Color fundus photograph, 45° FOV: 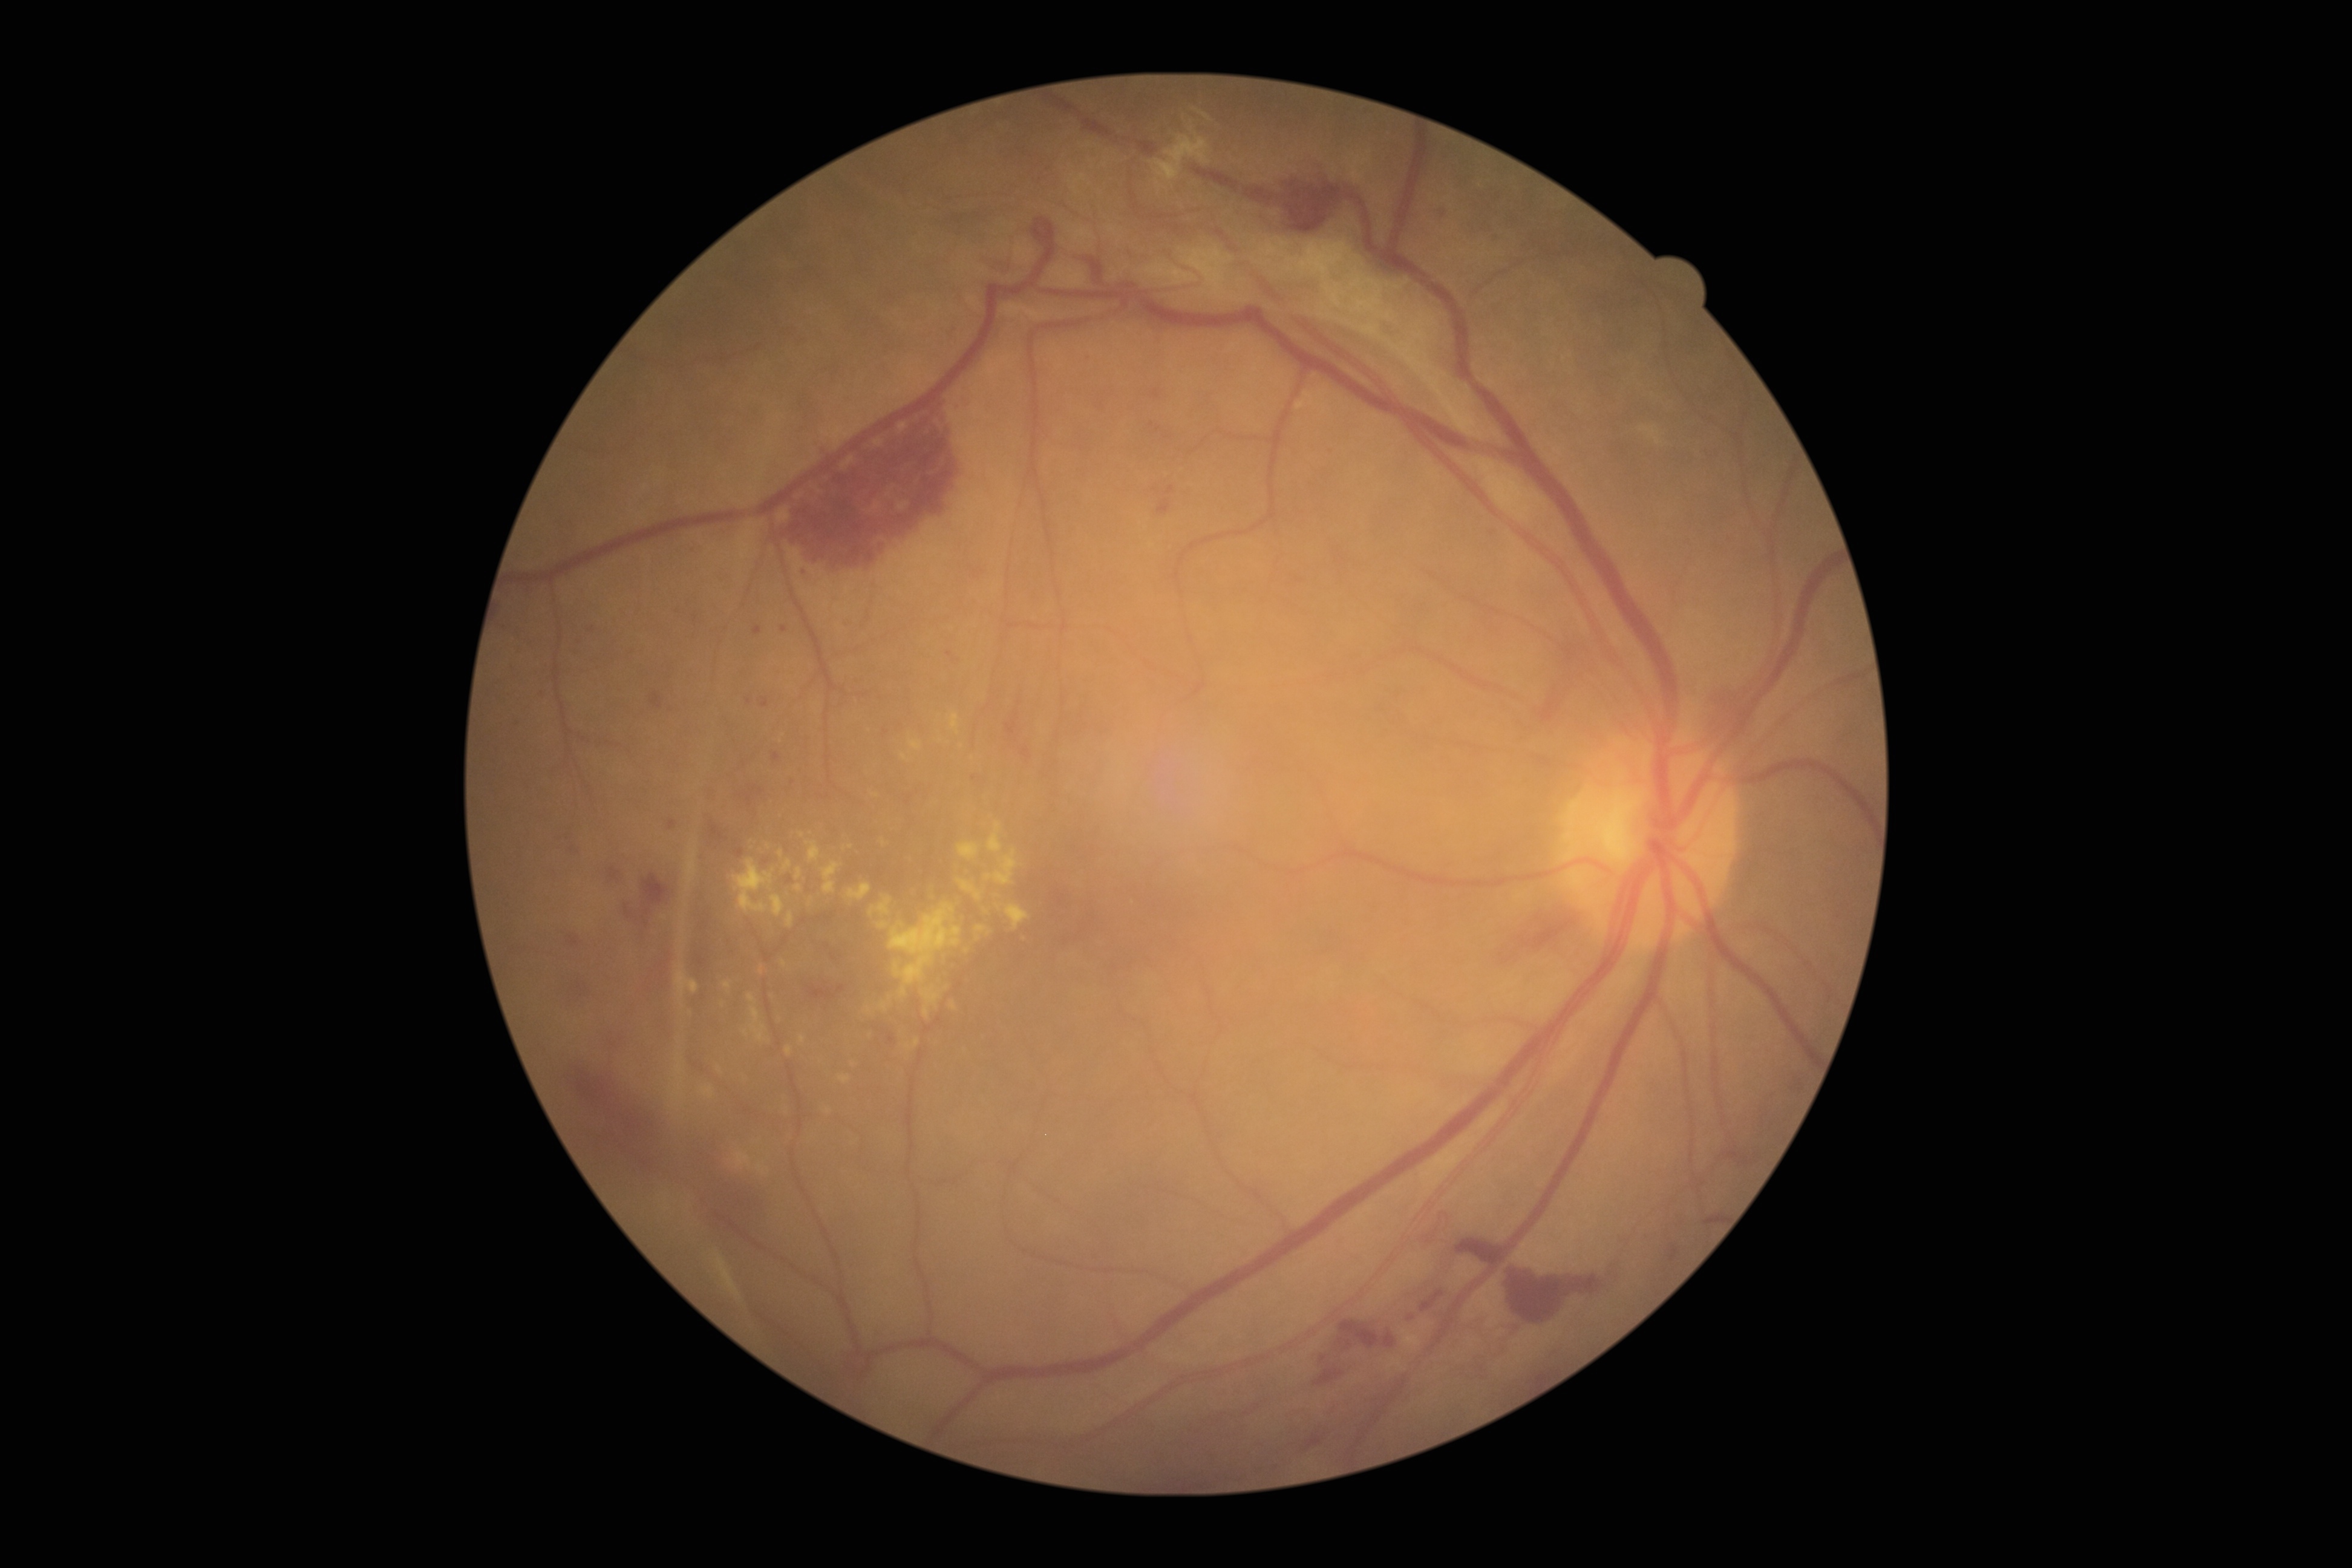
Diabetic retinopathy (DR): grade 4 (PDR).
Hemorrhages (HEs) include (x1=1305, y1=1433, x2=1323, y2=1451); (x1=1541, y1=642, x2=1595, y2=723); (x1=983, y1=252, x2=1021, y2=269); (x1=1456, y1=1238, x2=1504, y2=1265); (x1=650, y1=691, x2=662, y2=708); (x1=1704, y1=690, x2=1743, y2=730); (x1=746, y1=793, x2=753, y2=806); (x1=783, y1=407, x2=965, y2=568); (x1=837, y1=985, x2=845, y2=993); (x1=1277, y1=169, x2=1342, y2=233); (x1=1007, y1=722, x2=1018, y2=736); (x1=1315, y1=1368, x2=1345, y2=1386); (x1=608, y1=867, x2=620, y2=880); (x1=568, y1=936, x2=579, y2=947); (x1=693, y1=1131, x2=770, y2=1235).
HEs (small, approximate centers) near <point>755, 789</point>; <point>739, 852</point>; <point>1801, 1090</point>; <point>741, 795</point>.
No soft exudates (SEs) identified.
Microaneurysms (MAs) include (x1=1166, y1=486, x2=1175, y2=495); (x1=762, y1=697, x2=769, y2=707); (x1=668, y1=818, x2=677, y2=829); (x1=753, y1=626, x2=762, y2=635).
MAs (small, approximate centers) near <point>974, 777</point>; <point>886, 731</point>; <point>749, 702</point>; <point>776, 756</point>; <point>695, 618</point>; <point>571, 848</point>; <point>784, 629</point>.
Hard exudates (EXs) include (x1=675, y1=961, x2=699, y2=1007); (x1=781, y1=959, x2=788, y2=967); (x1=889, y1=903, x2=962, y2=998); (x1=846, y1=883, x2=872, y2=901); (x1=787, y1=912, x2=793, y2=929); (x1=770, y1=895, x2=786, y2=918); (x1=921, y1=989, x2=939, y2=1005); (x1=823, y1=862, x2=841, y2=893); (x1=702, y1=1086, x2=714, y2=1098); (x1=923, y1=1006, x2=929, y2=1017); (x1=786, y1=1045, x2=792, y2=1057); (x1=724, y1=982, x2=733, y2=988).
EXs (small, approximate centers) near <point>868, 1009</point>; <point>720, 1070</point>; <point>761, 970</point>; <point>904, 756</point>.